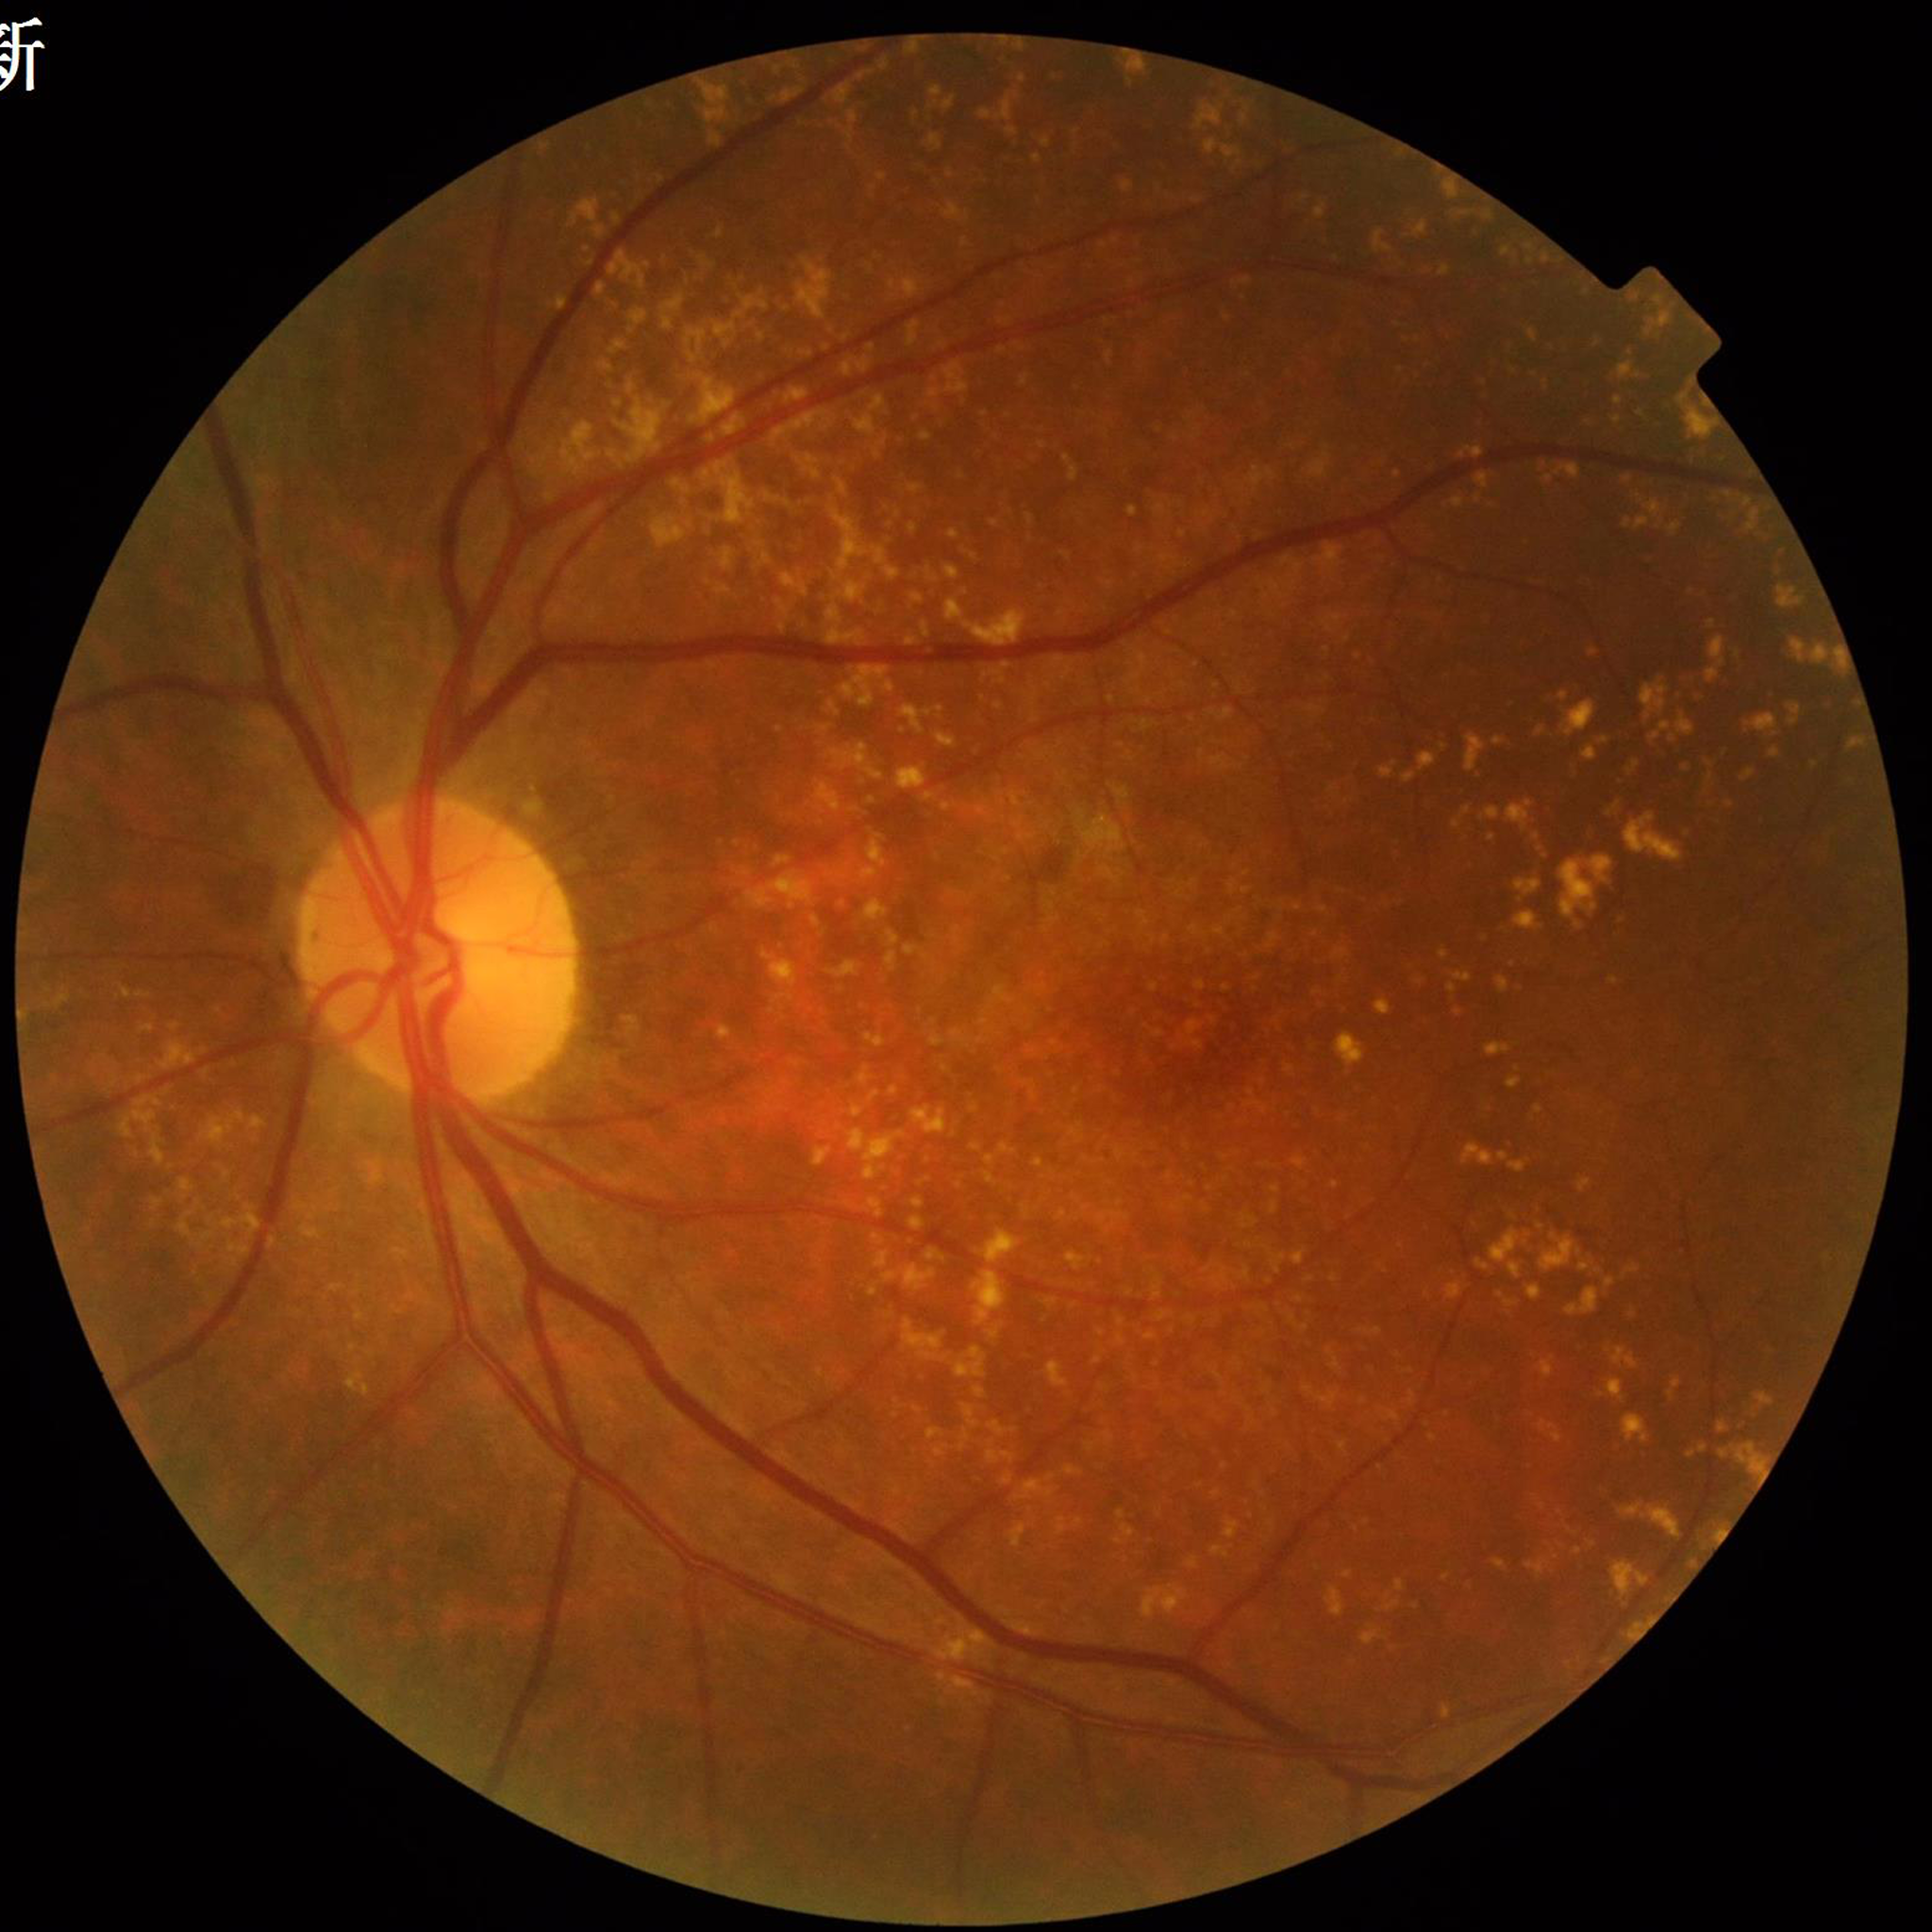
Fundus image of an eye with age-related macular degeneration (AMD). Automated quality assessment: no quality issues identified.